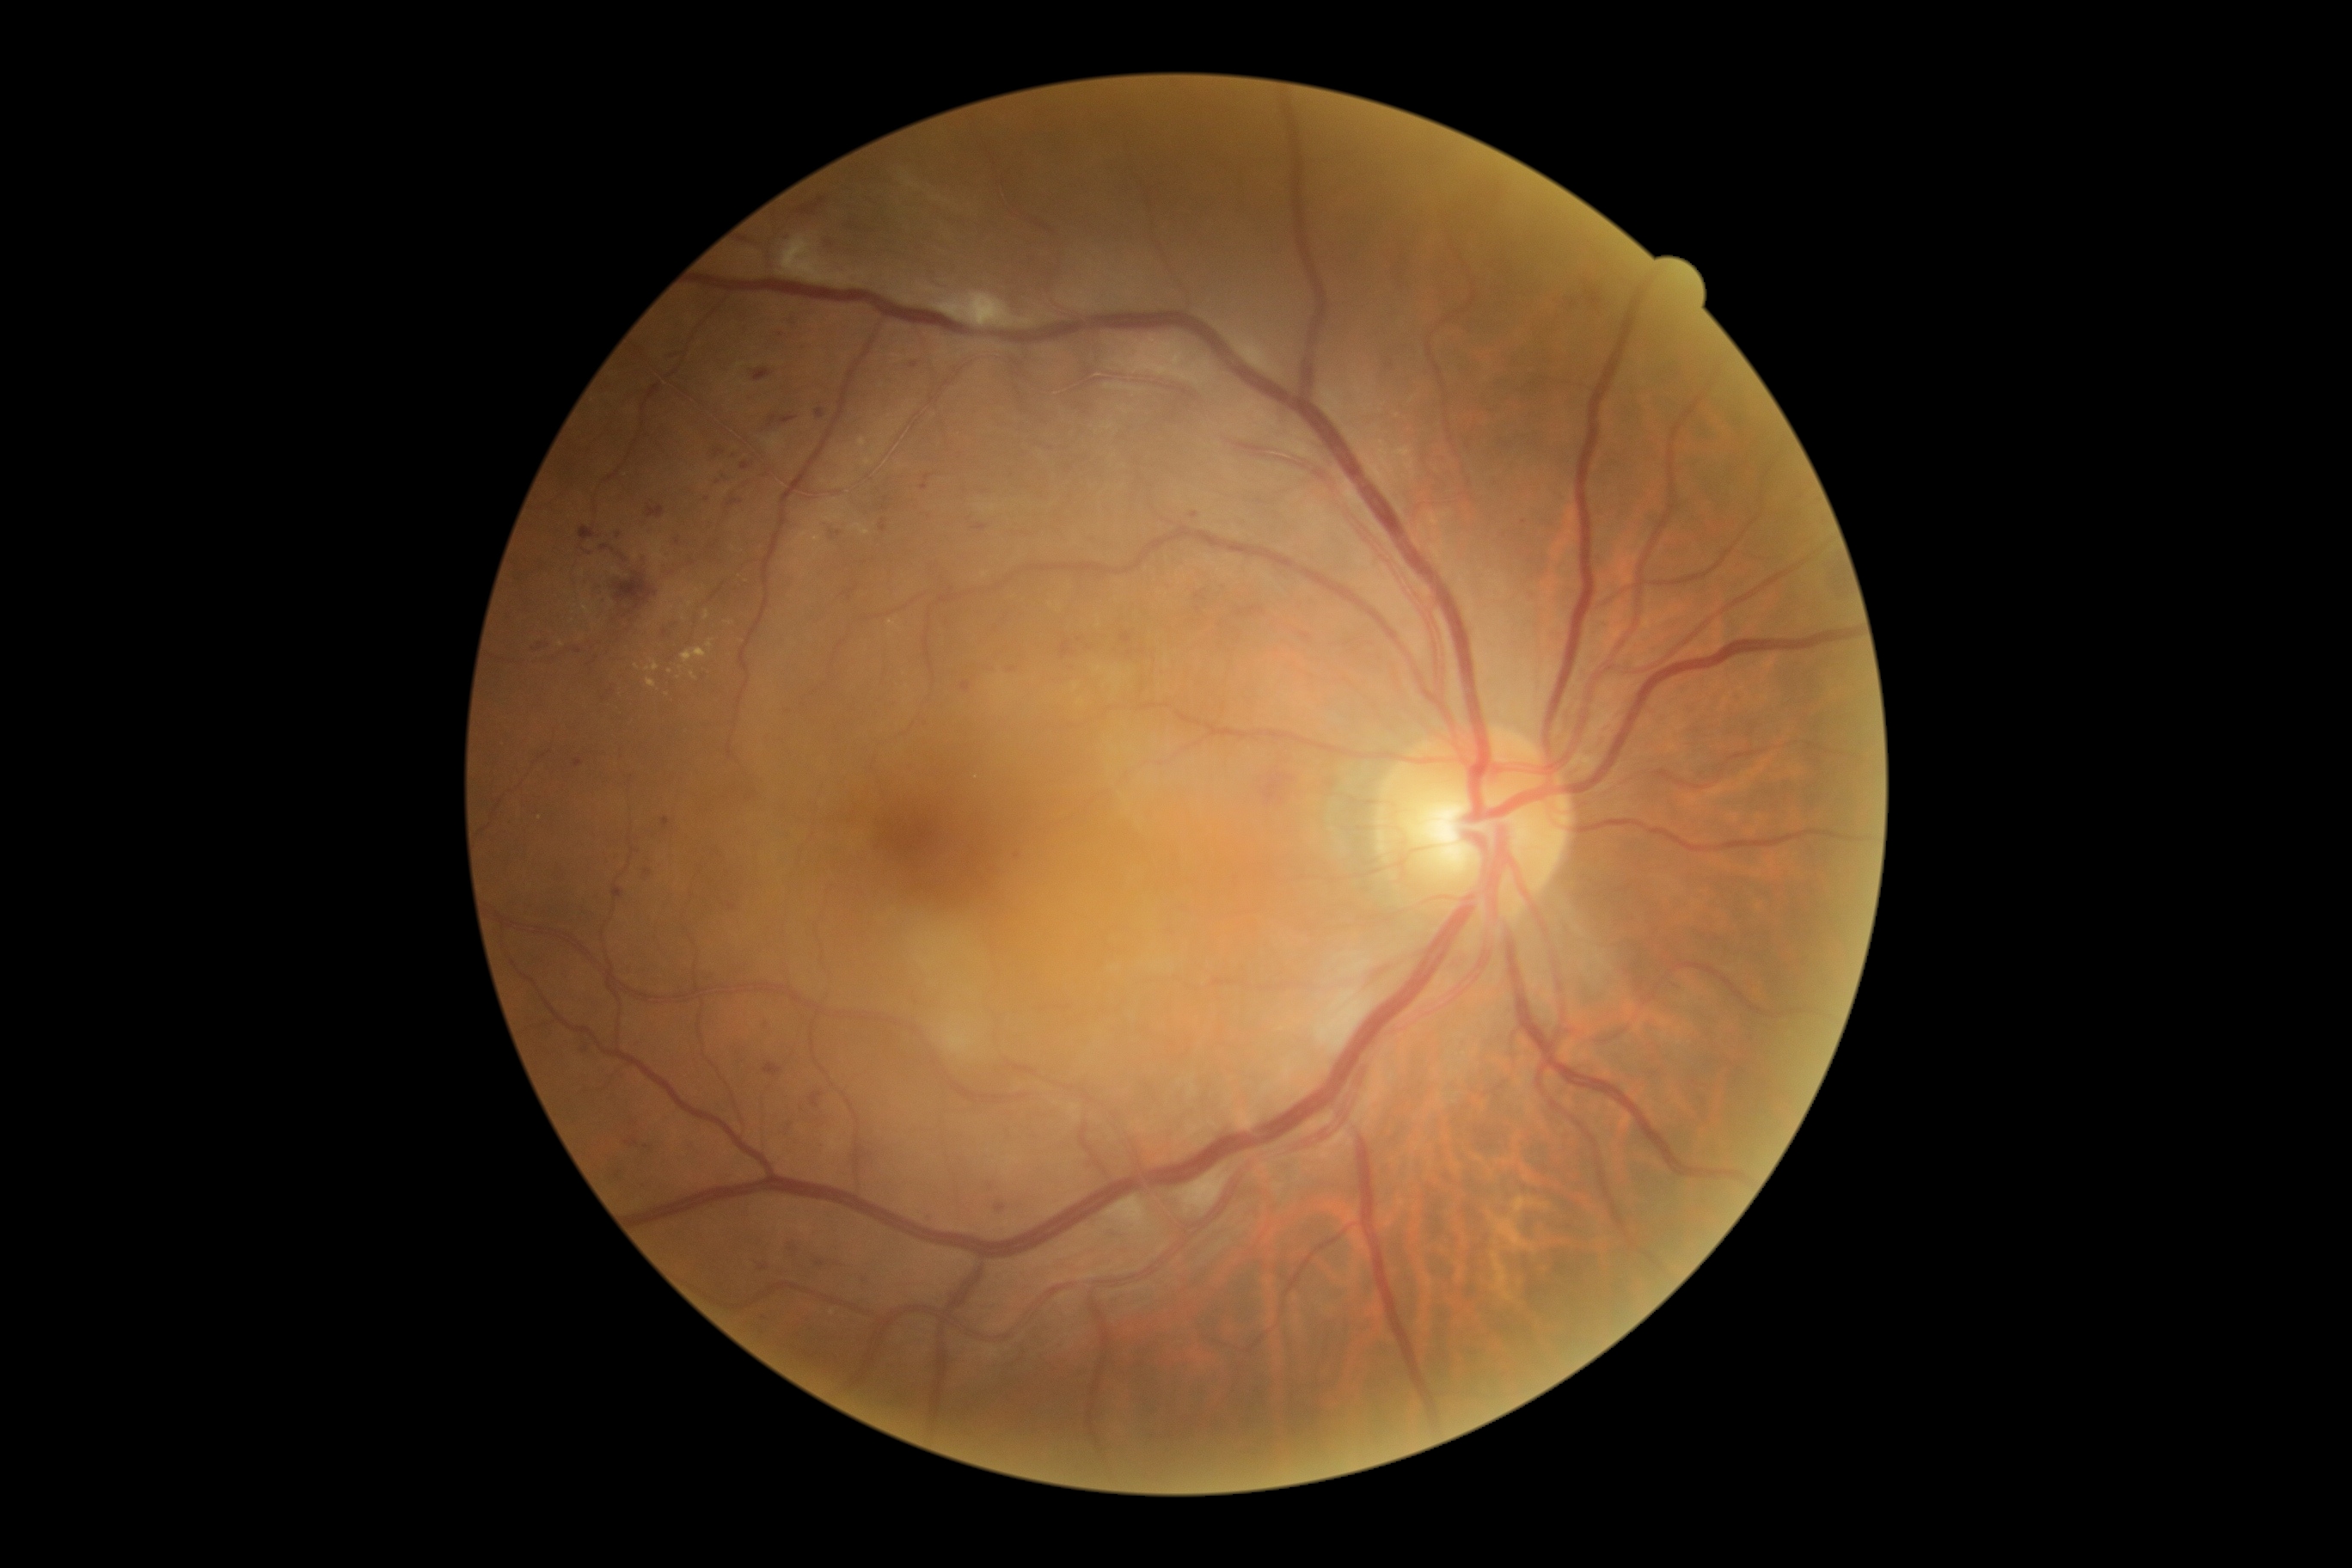 Diabetic retinopathy severity is 2/4.